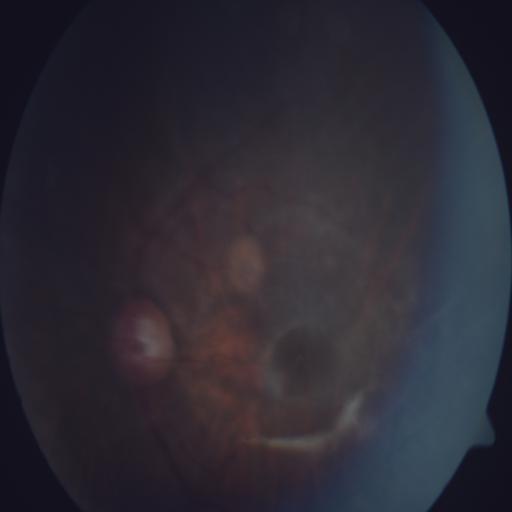 Diagnosis (4): MS (macular scar), MYA (myopia), TSLN (tessellation), MH (media haze).